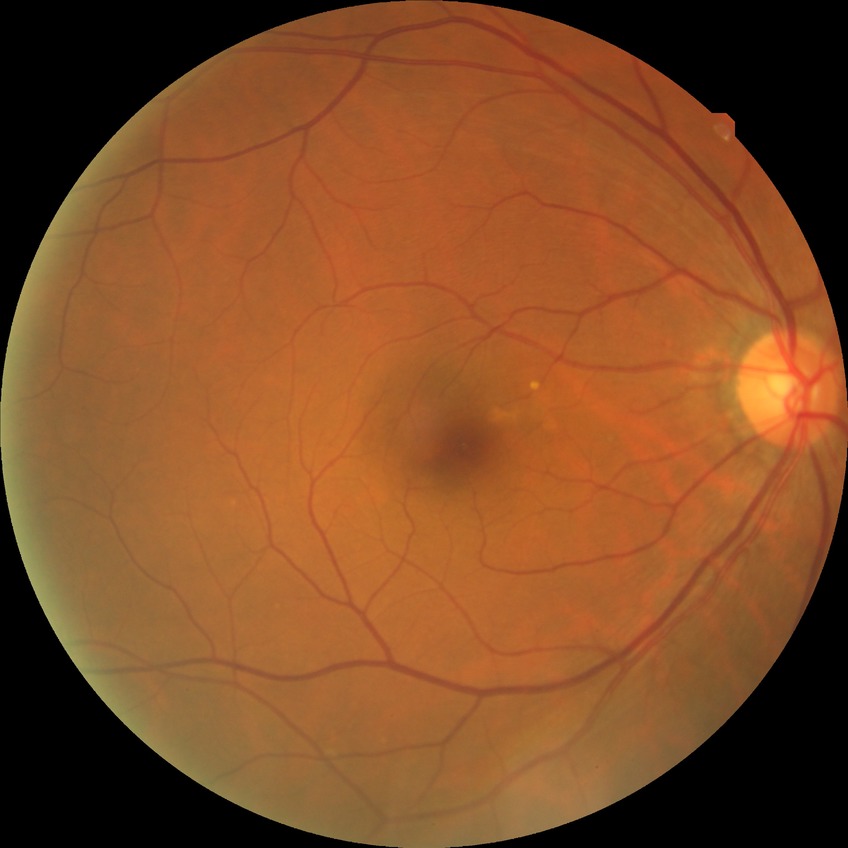
diabetic retinopathy (DR) = NDR (no diabetic retinopathy).